45° field of view: 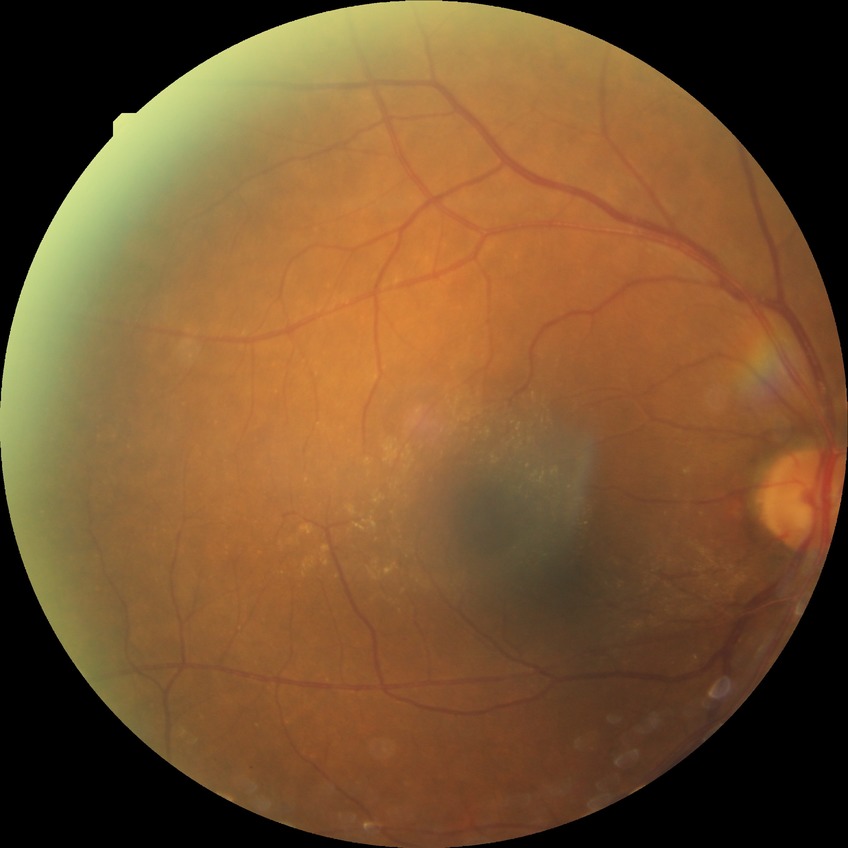

Diabetic retinopathy (DR): simple diabetic retinopathy (SDR).